Posterior pole color fundus photograph:
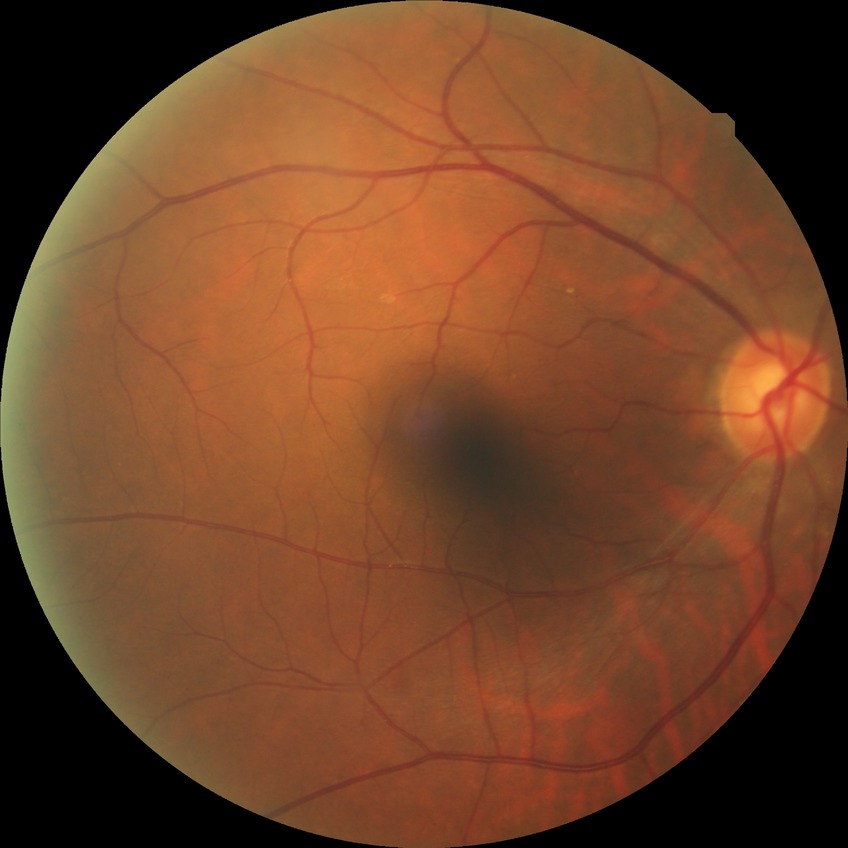
Diabetic retinopathy (DR) is NDR (no diabetic retinopathy).